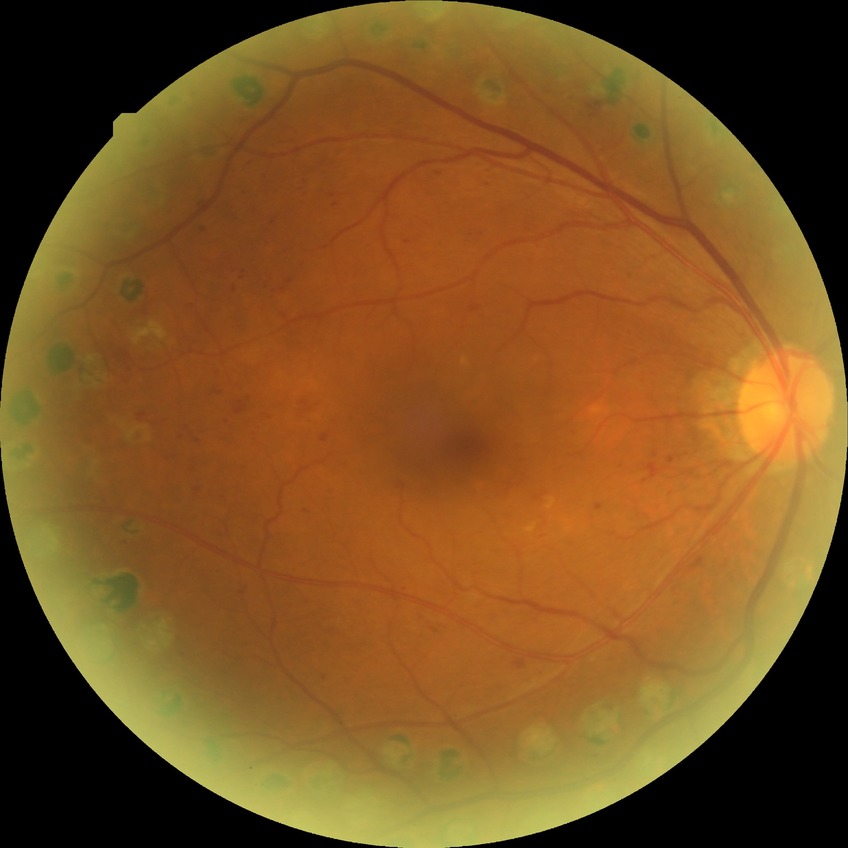
Diabetic retinopathy (DR): proliferative diabetic retinopathy (PDR).